Infant wide-field retinal image. 1440 by 1080 pixels — 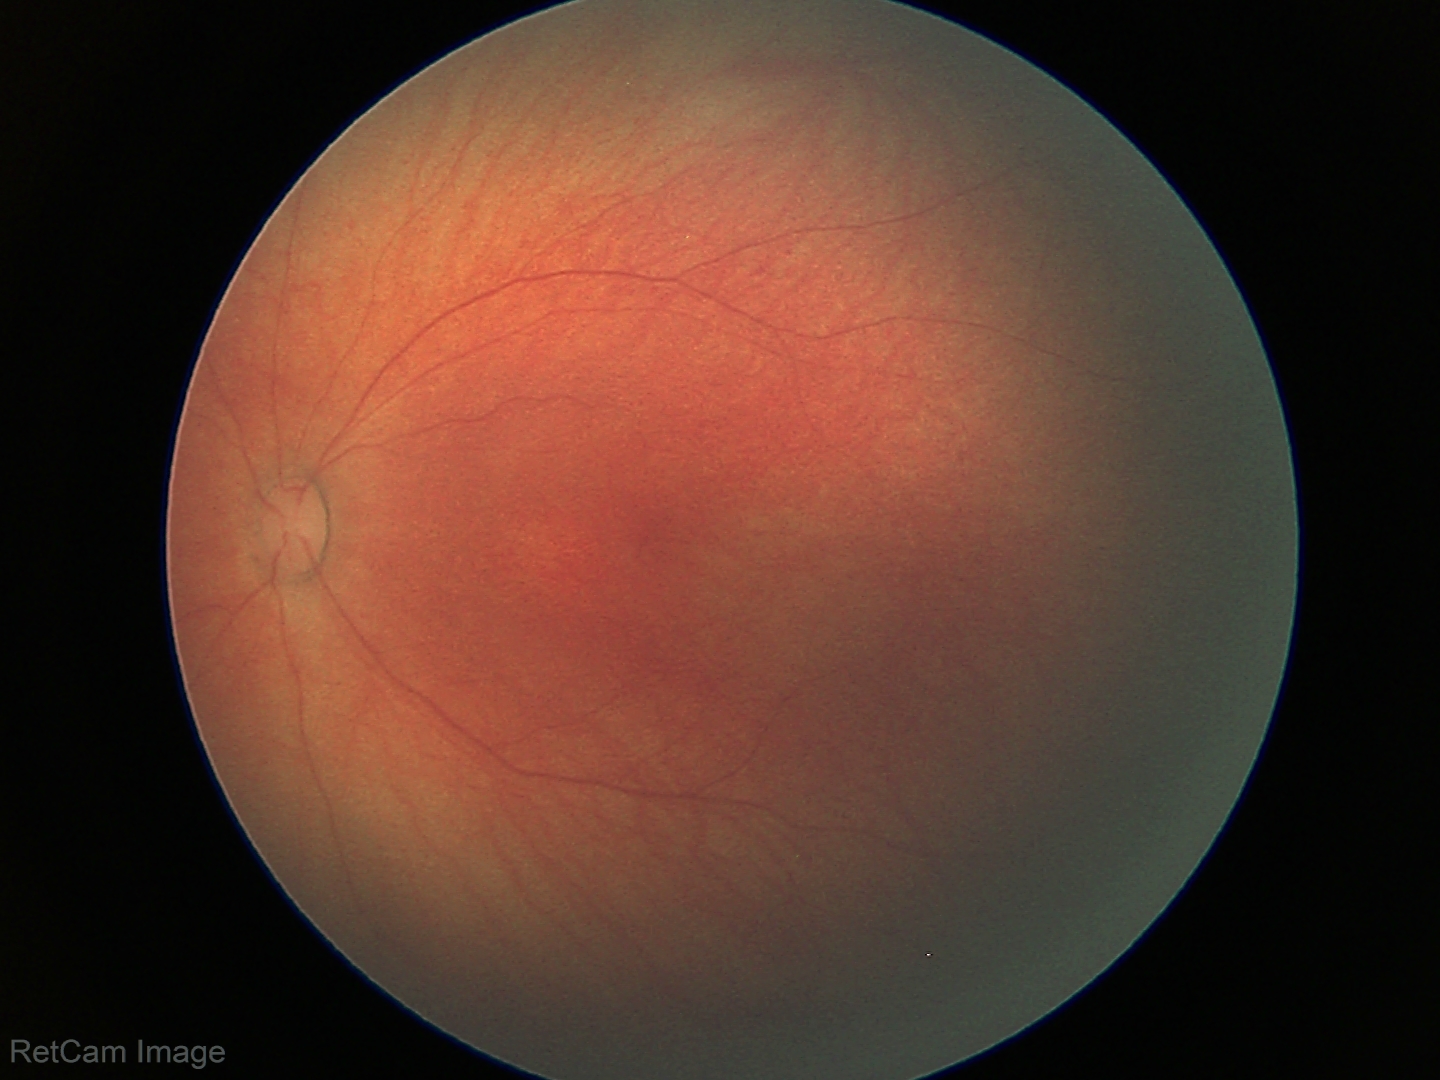 Screening: physiological finding.